Field includes the optic disc and macula · camera: Topcon TRC-50DX — 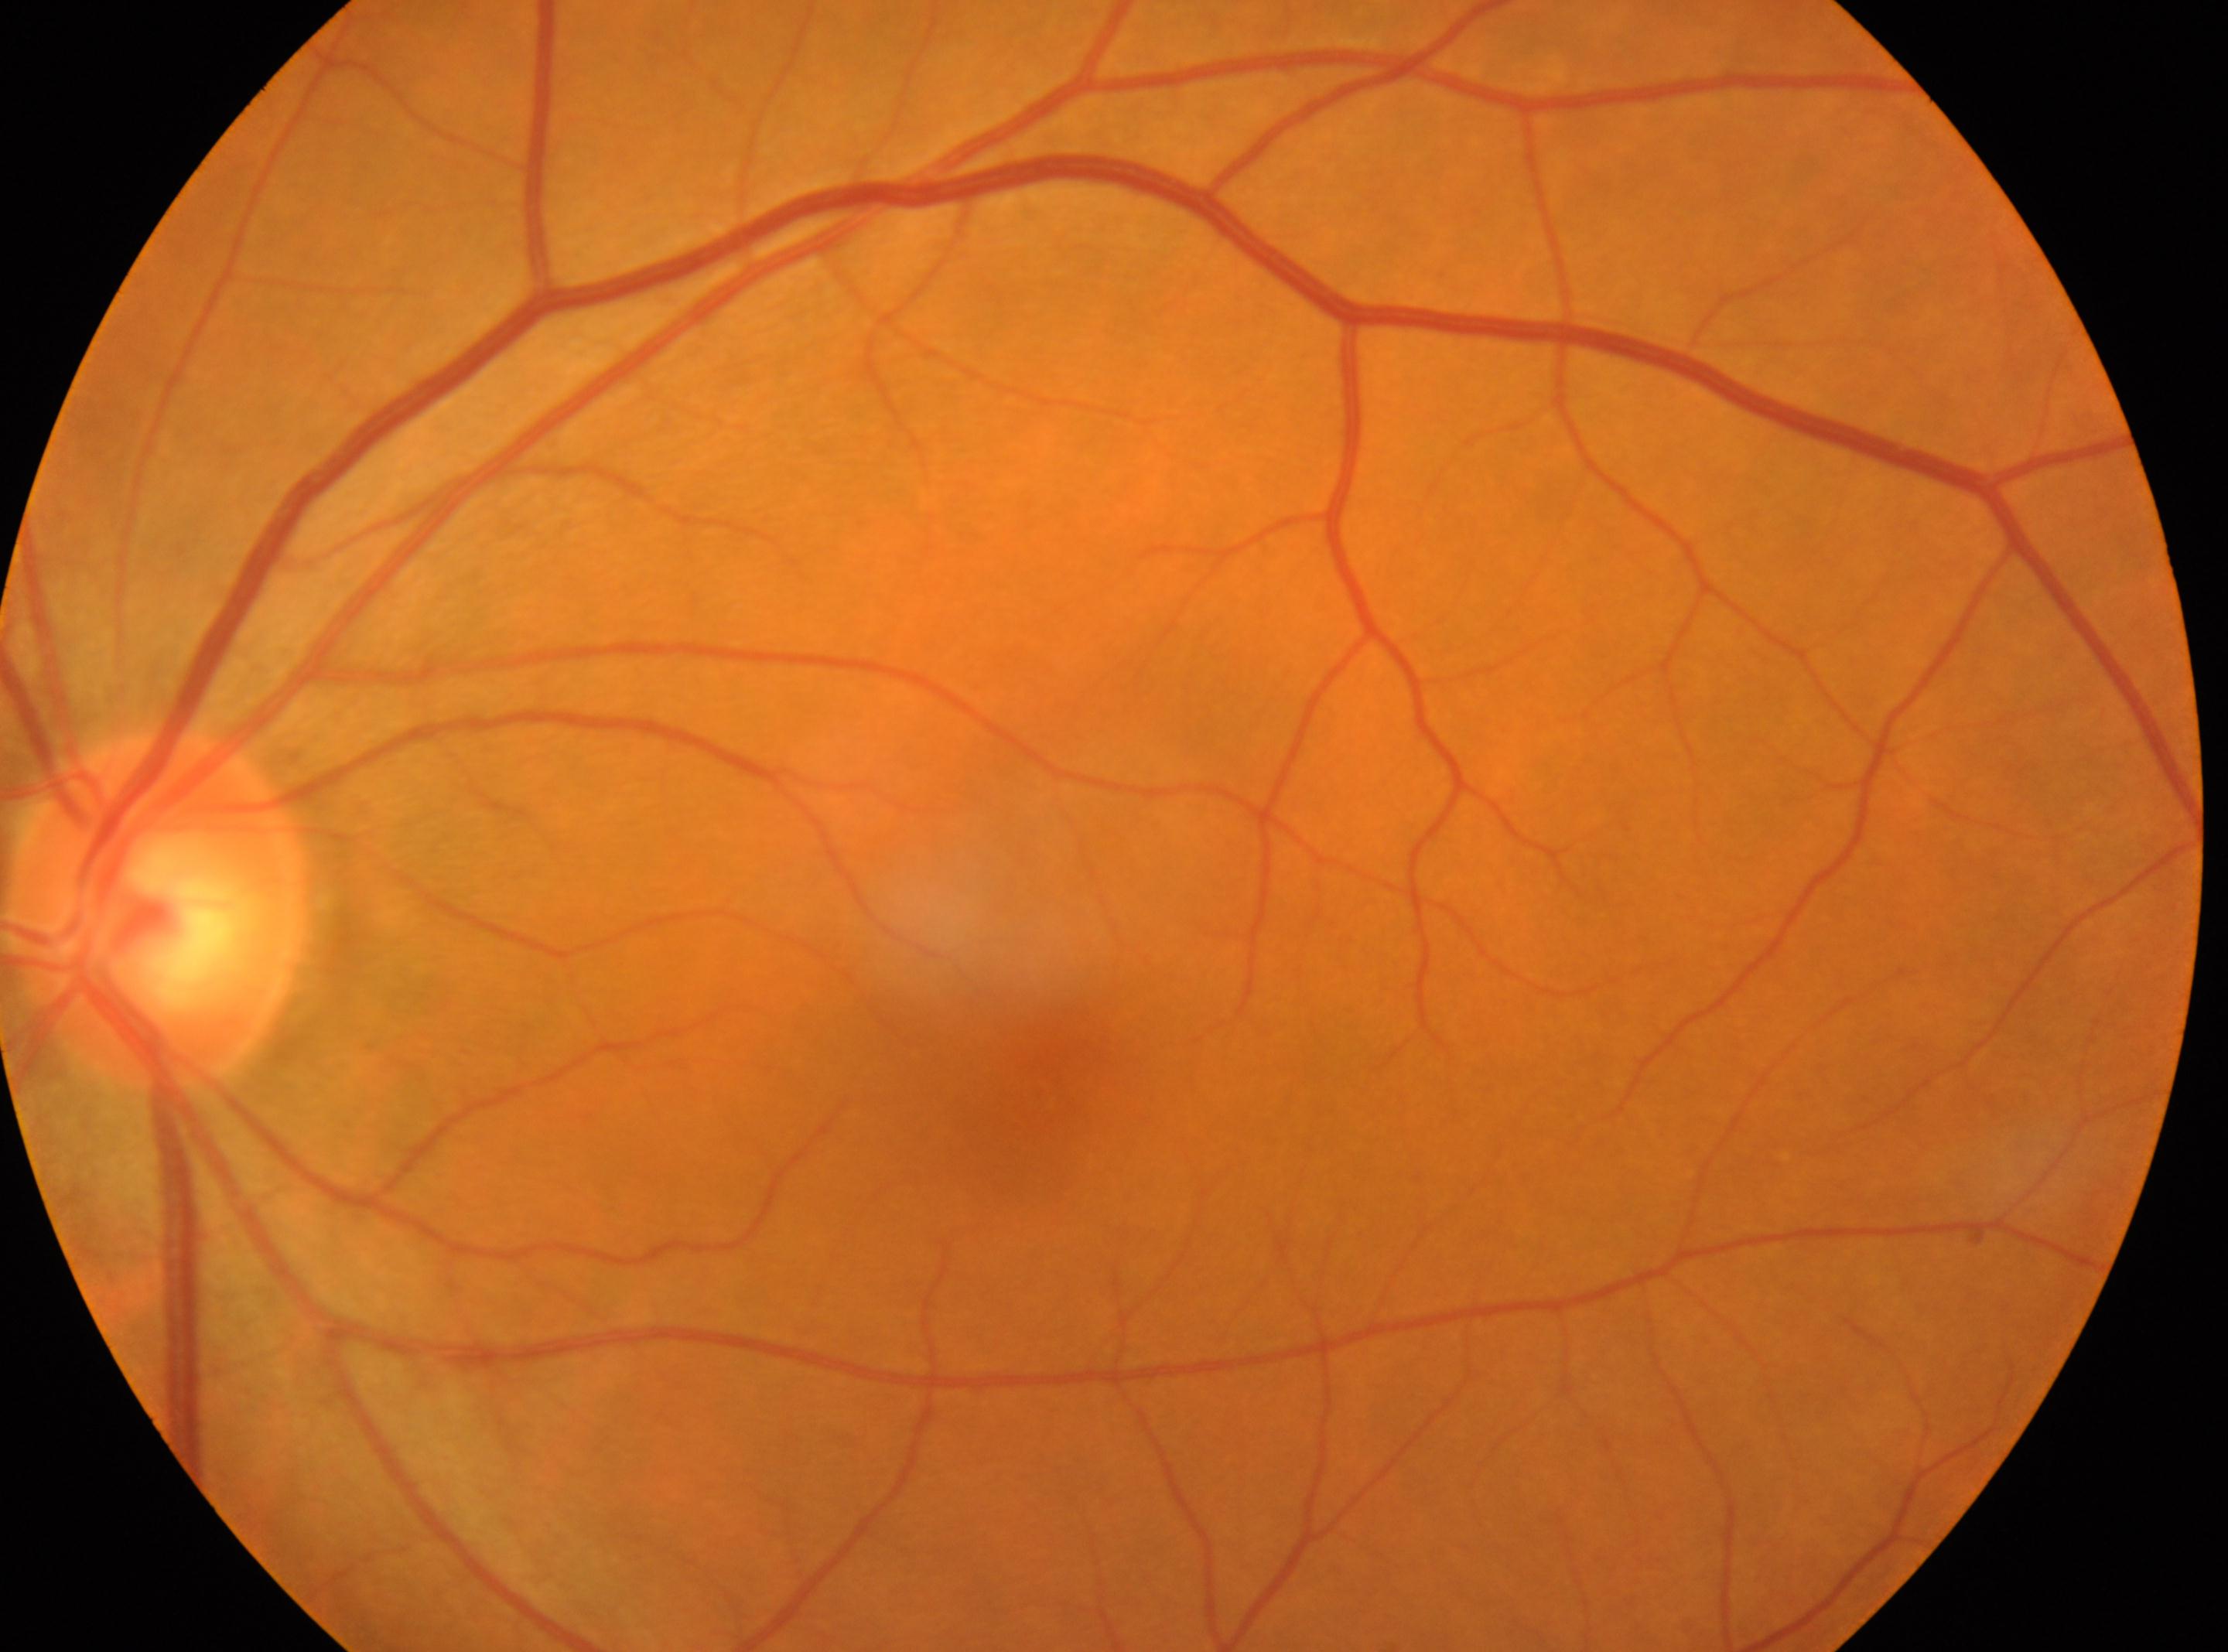 Optic nerve head: 156px, 910px.
No diabetic retinal disease findings.
DR grade: 0 (no apparent retinopathy).
The fovea center is at 1043px, 1094px.
Eye: left.